Wide-field fundus photograph of an infant; Clarity RetCam 3, 130° FOV:
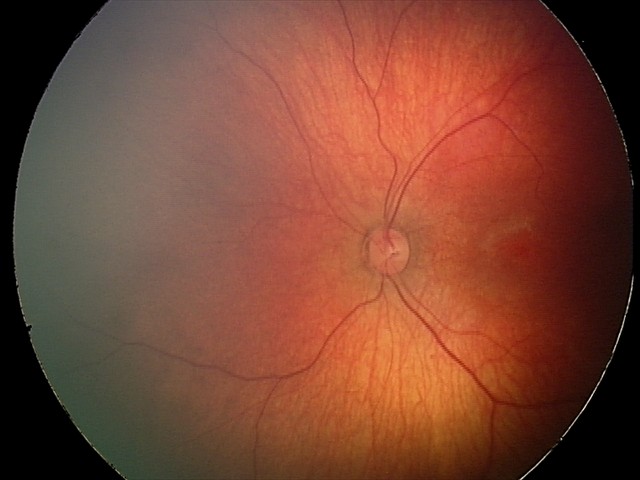

Diagnosis from this screening exam: retinal hemorrhages.